Wide-field fundus photograph of an infant · 640 by 480 pixels:
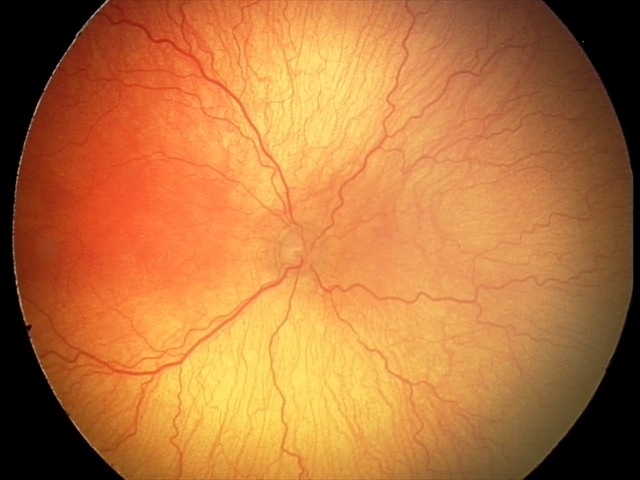 With plus disease. Diagnosis from this screening exam: aggressive retinopathy of prematurity.